2352 x 1568 pixels; CFP; 45° FOV:
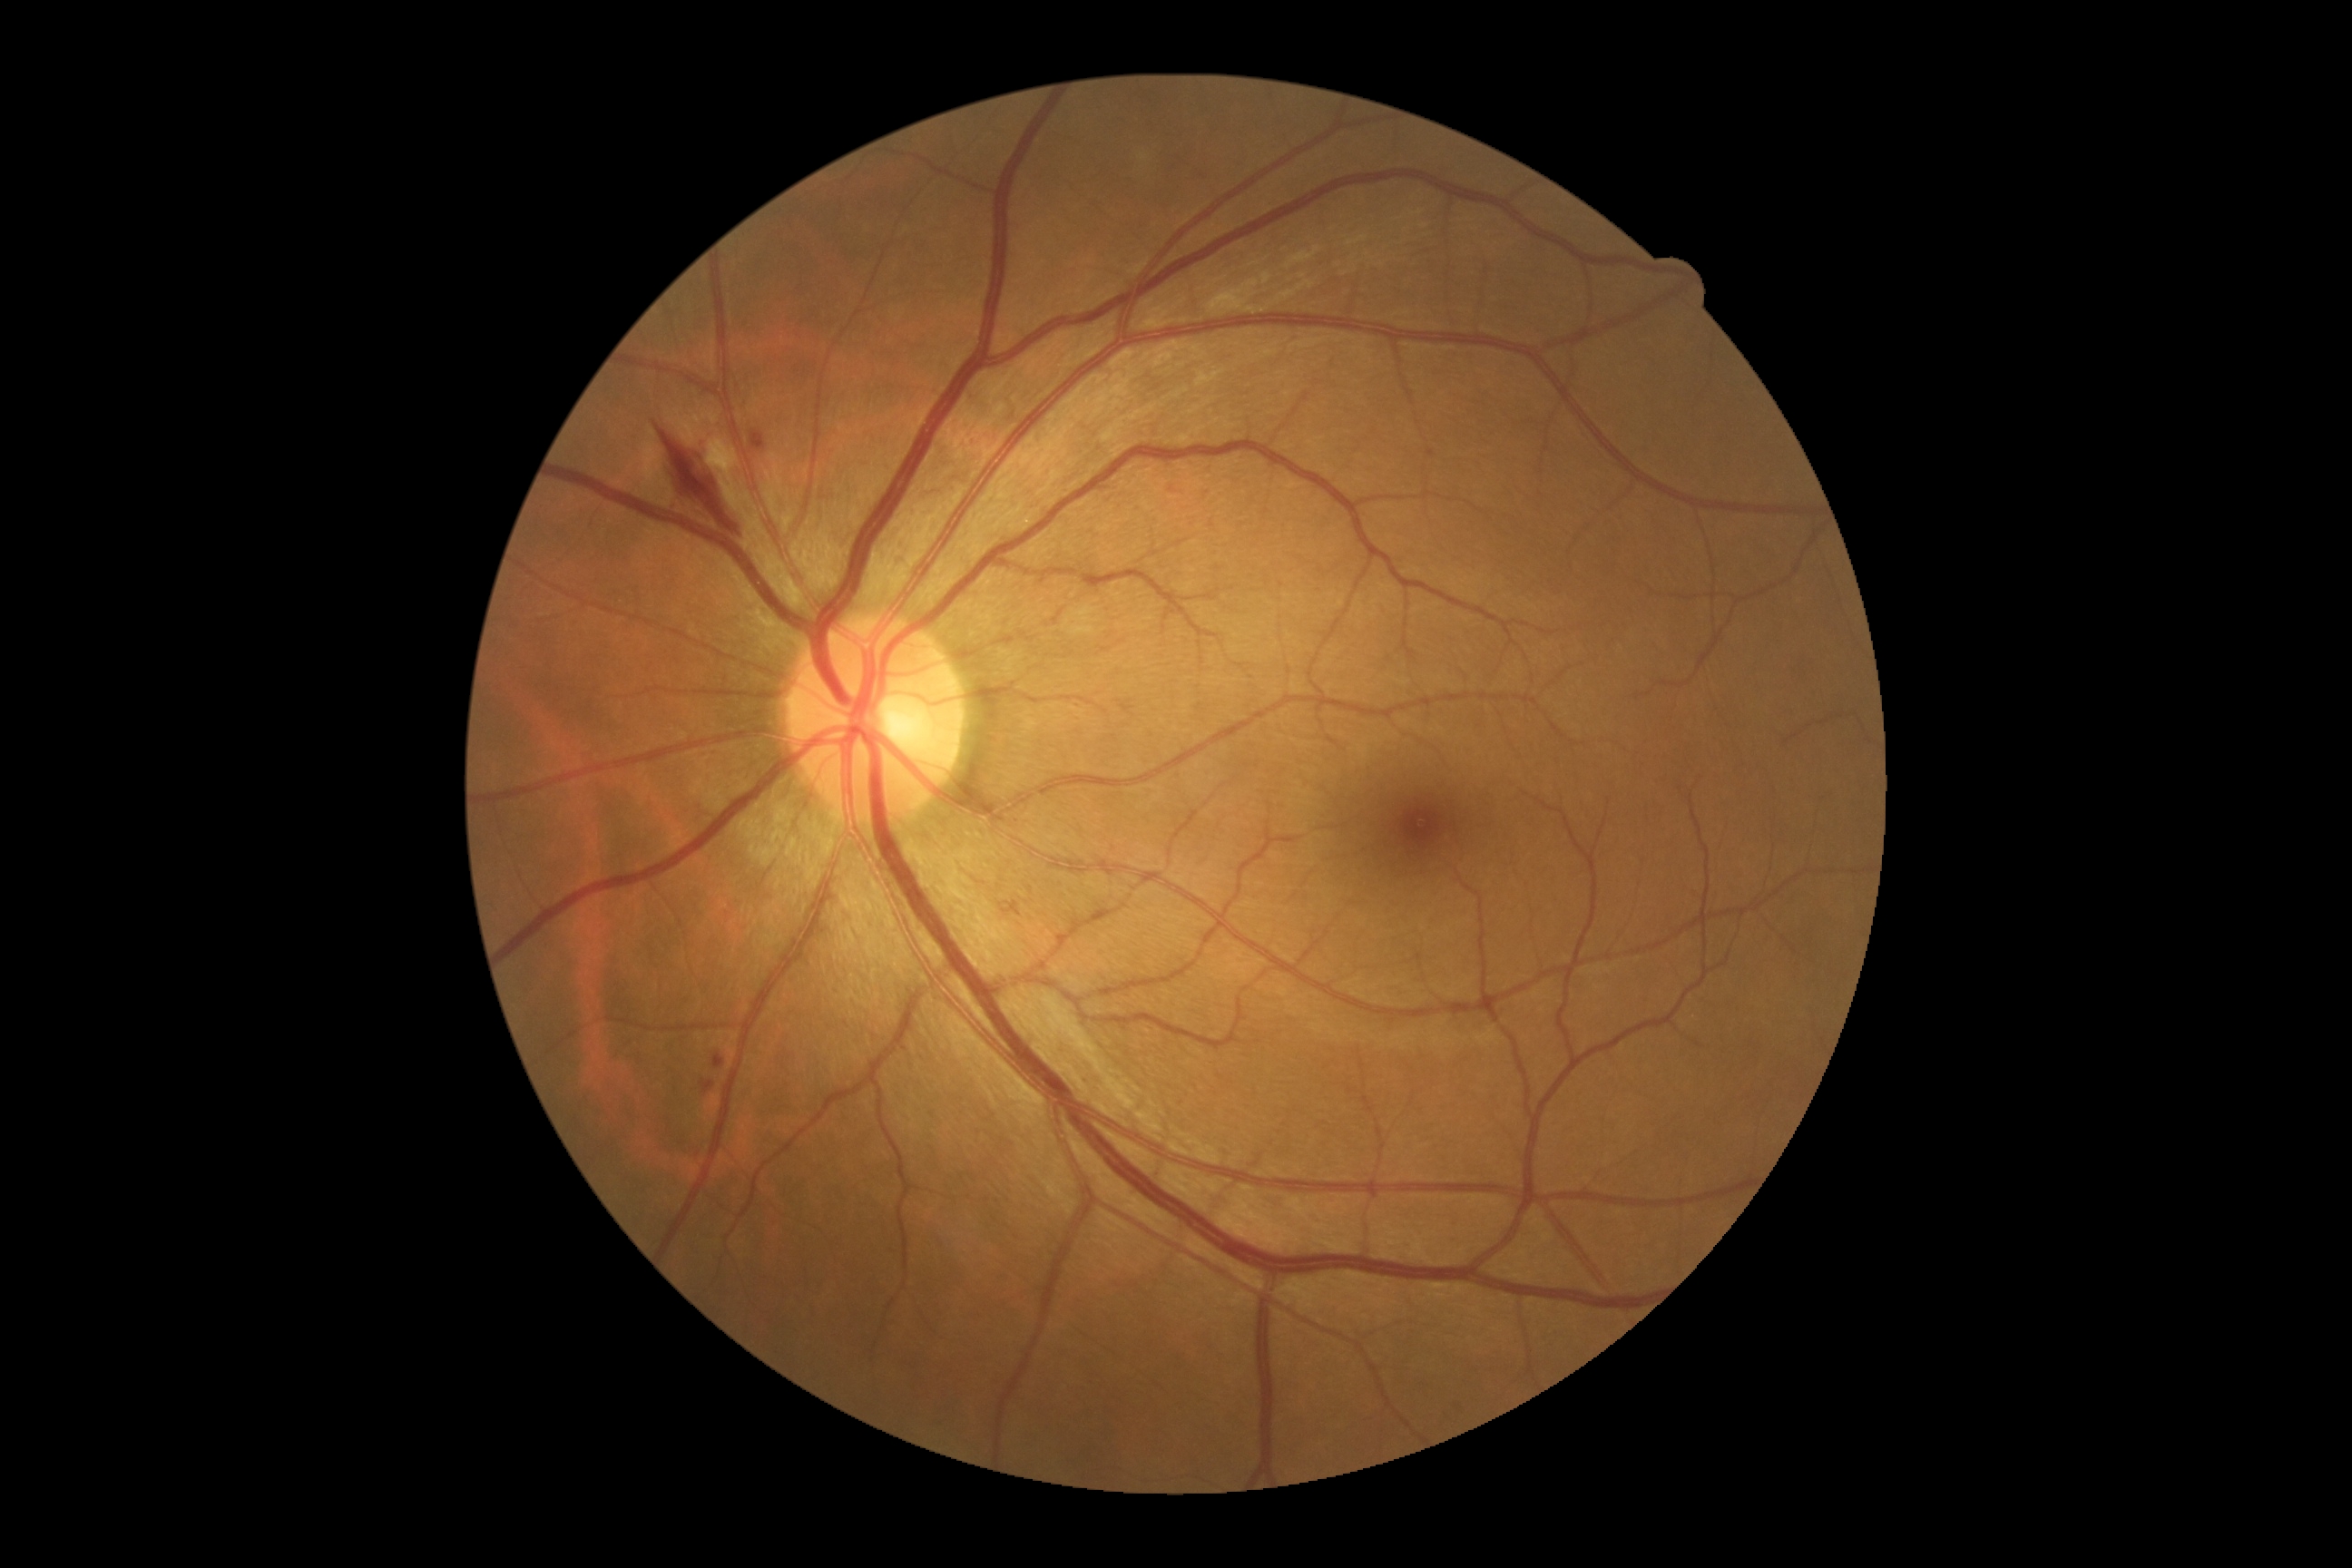

DR class: non-proliferative diabetic retinopathy
retinopathy grade: 2